Natus RetCam Envision, 130° FOV · wide-field fundus photograph from neonatal ROP screening · 1440x1080
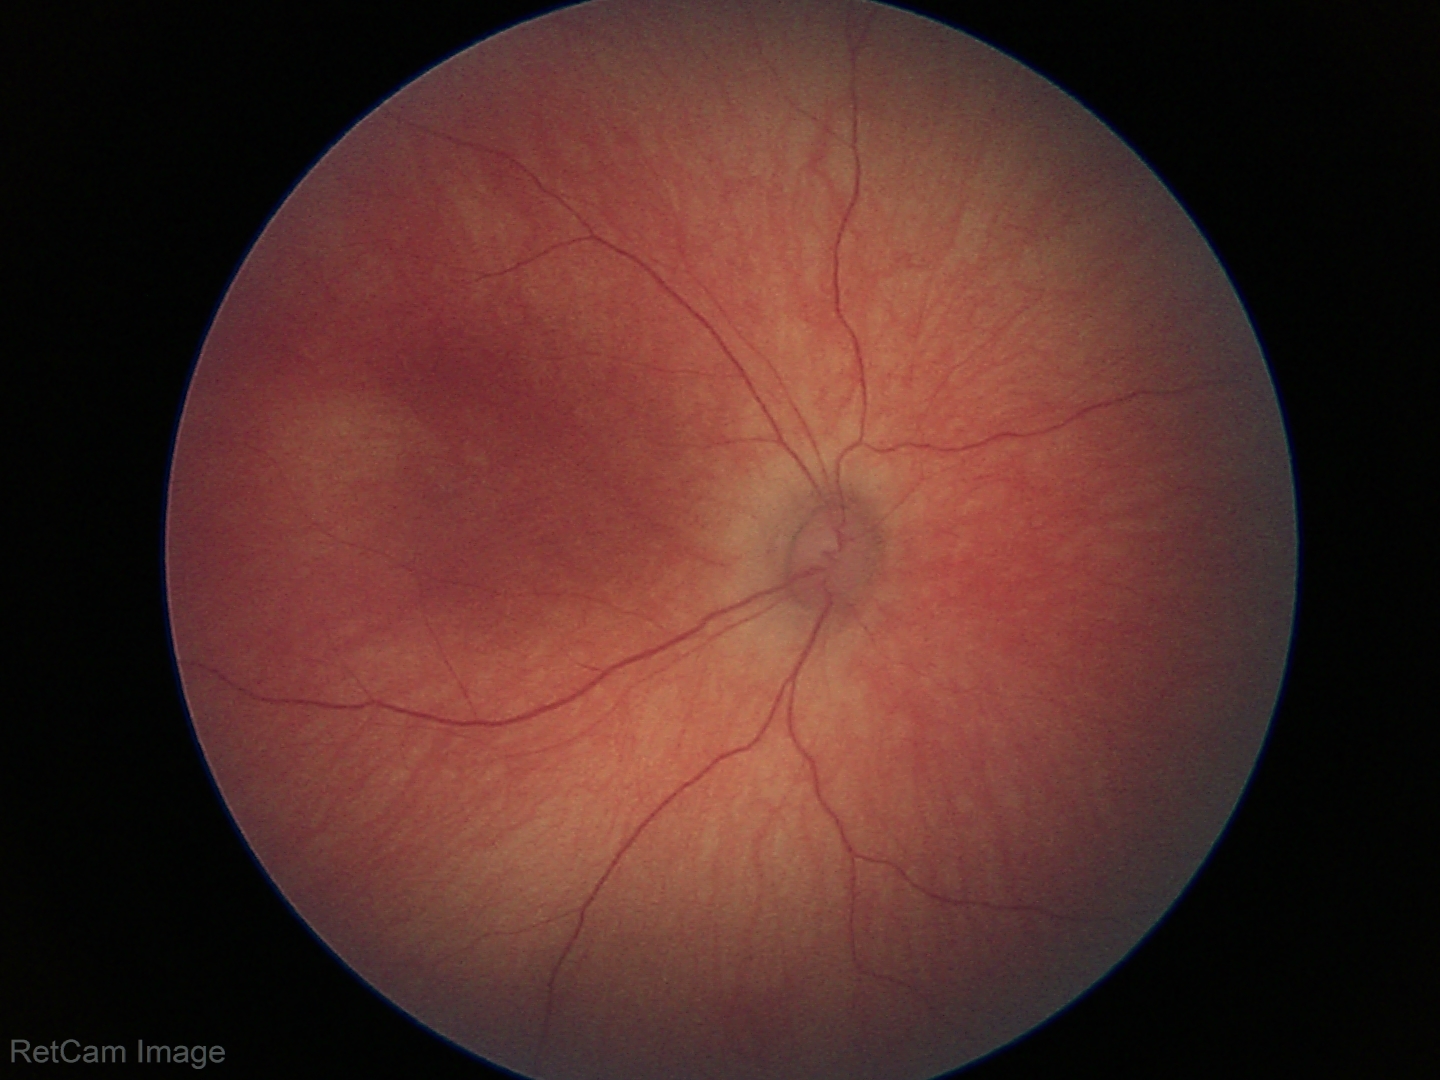

Screening diagnosis: physiological finding.